Fundus photo; optic disc region crop:
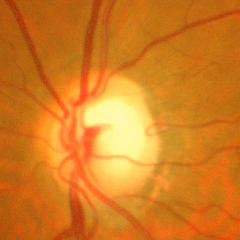
Demonstrates advanced glaucomatous optic neuropathy.